45° field of view. 2352x1568. Color fundus photograph:
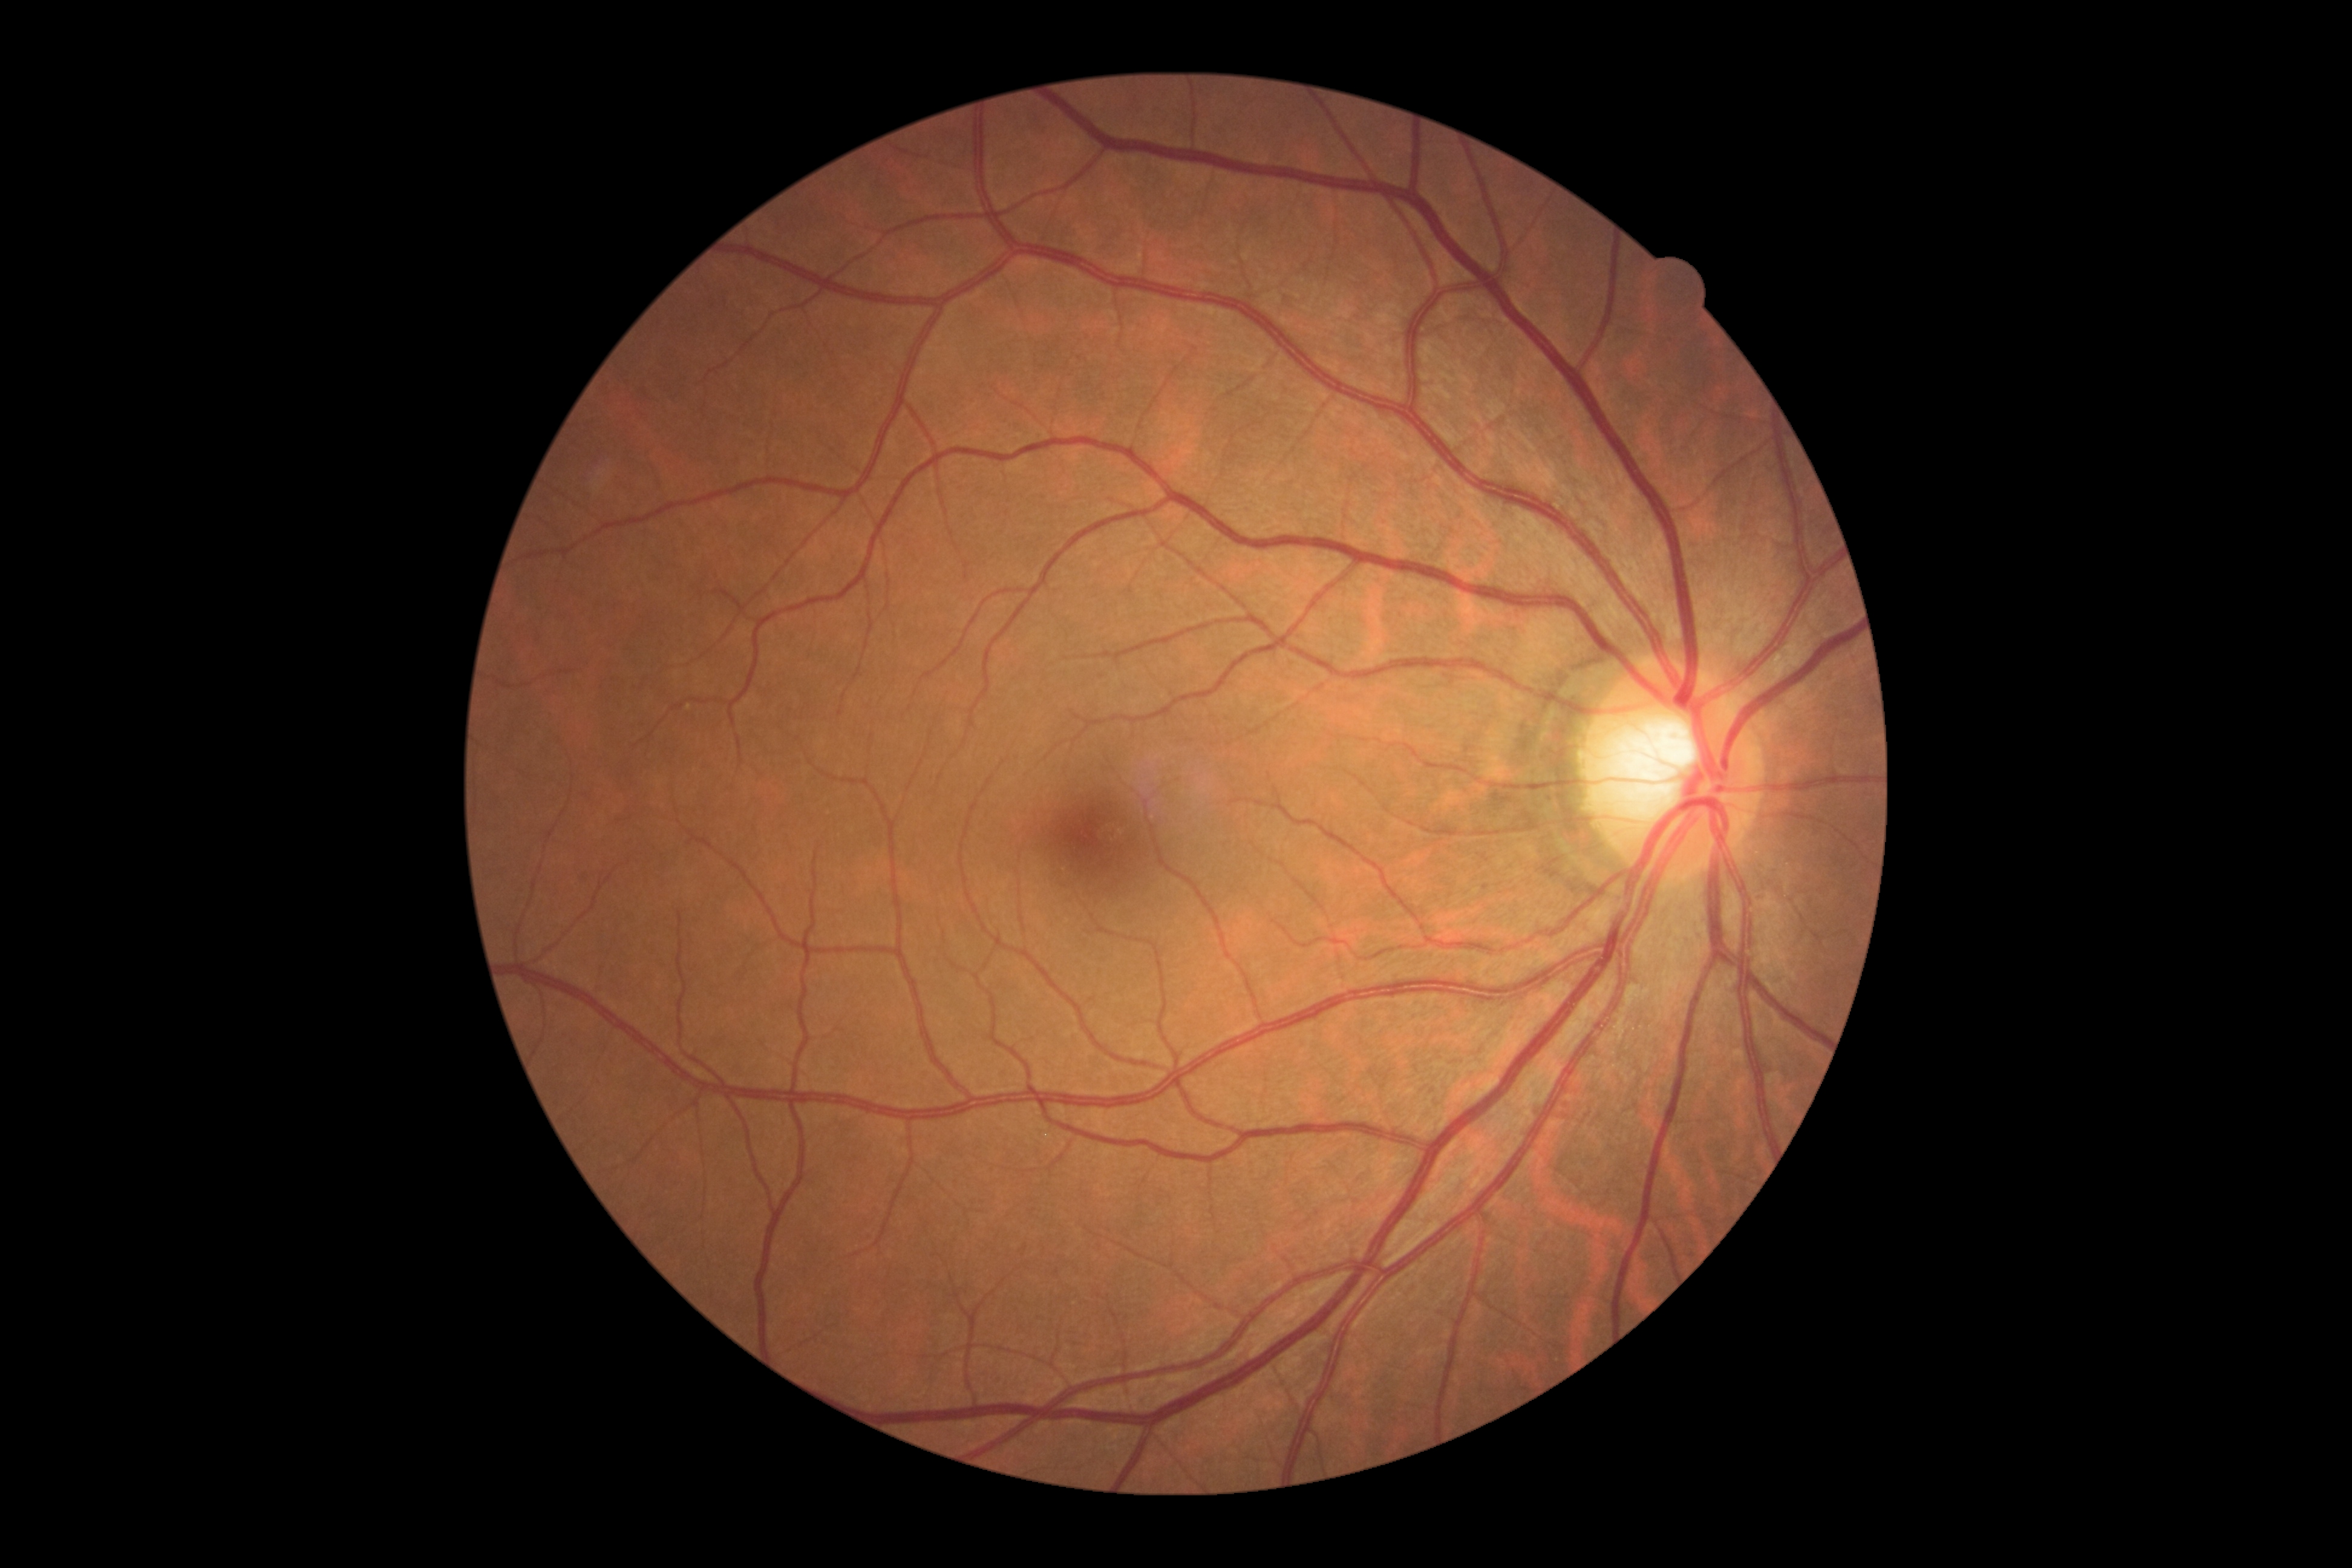
{"dr_grade": "grade 0"}